Infant wide-field fundus photograph
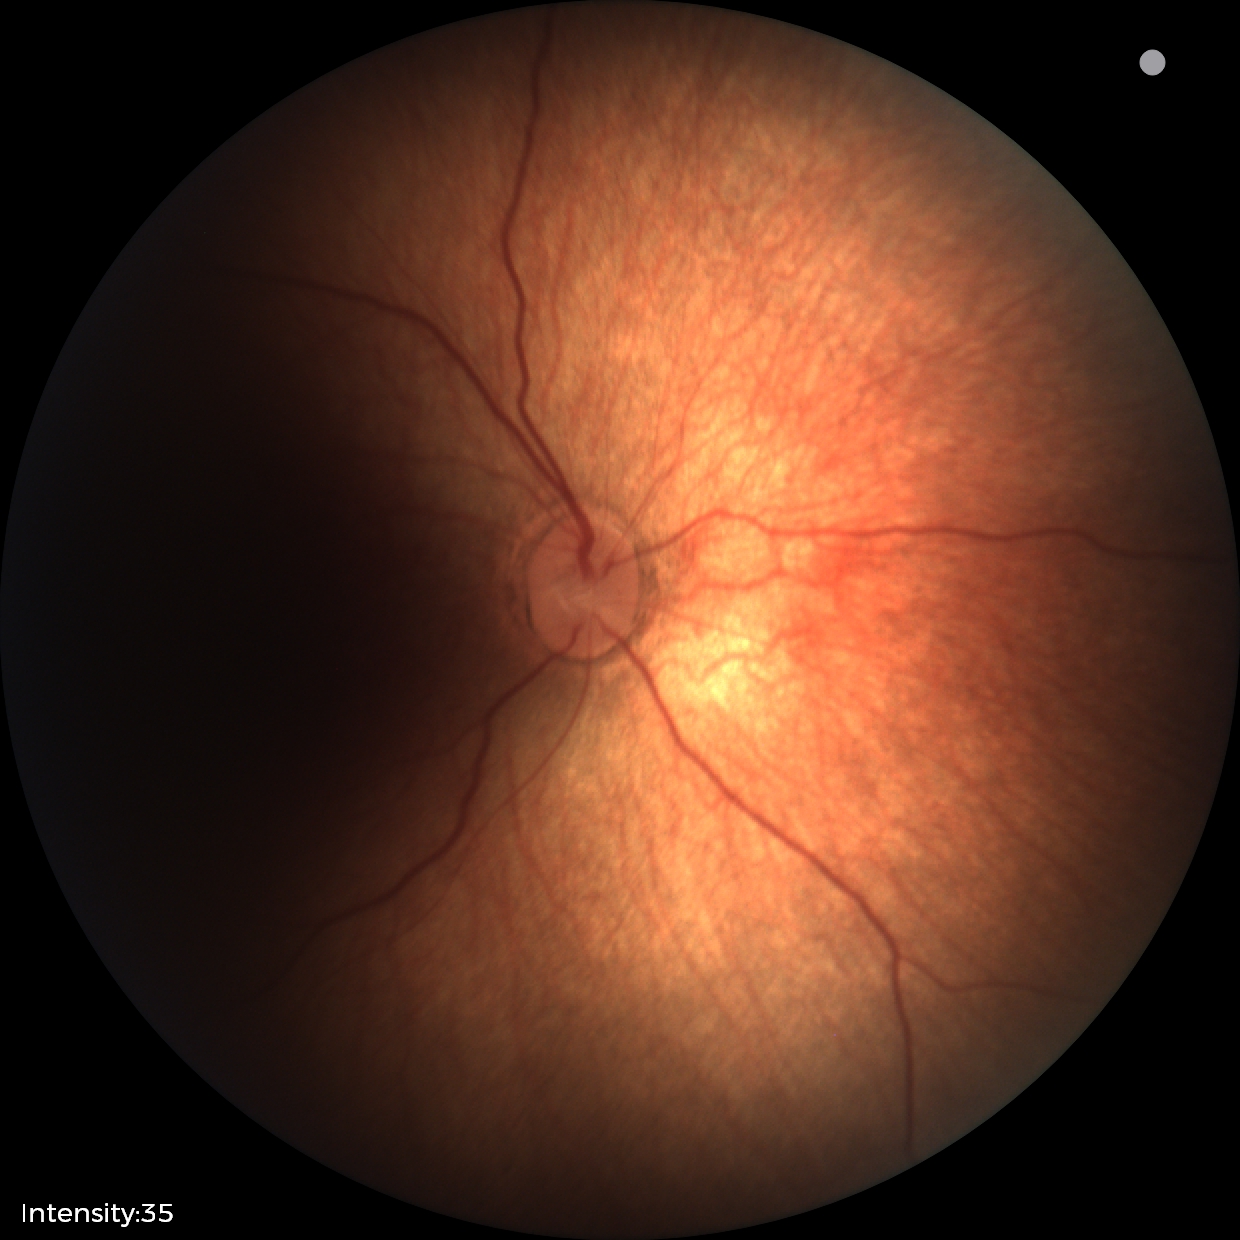

Physiological retinal appearance for postconceptual age.